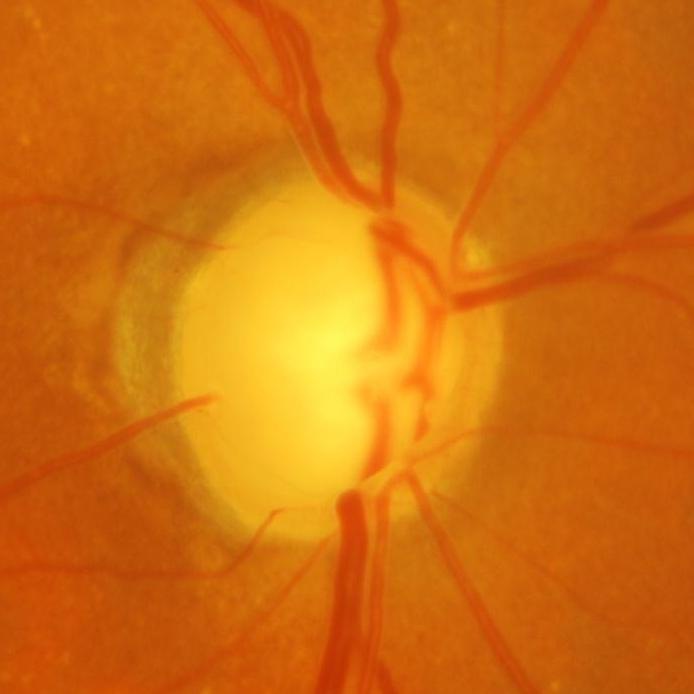
Q: Glaucoma assessment?
A: Yes — glaucoma.